Retinal fundus photograph · 2212 by 1659 pixels — 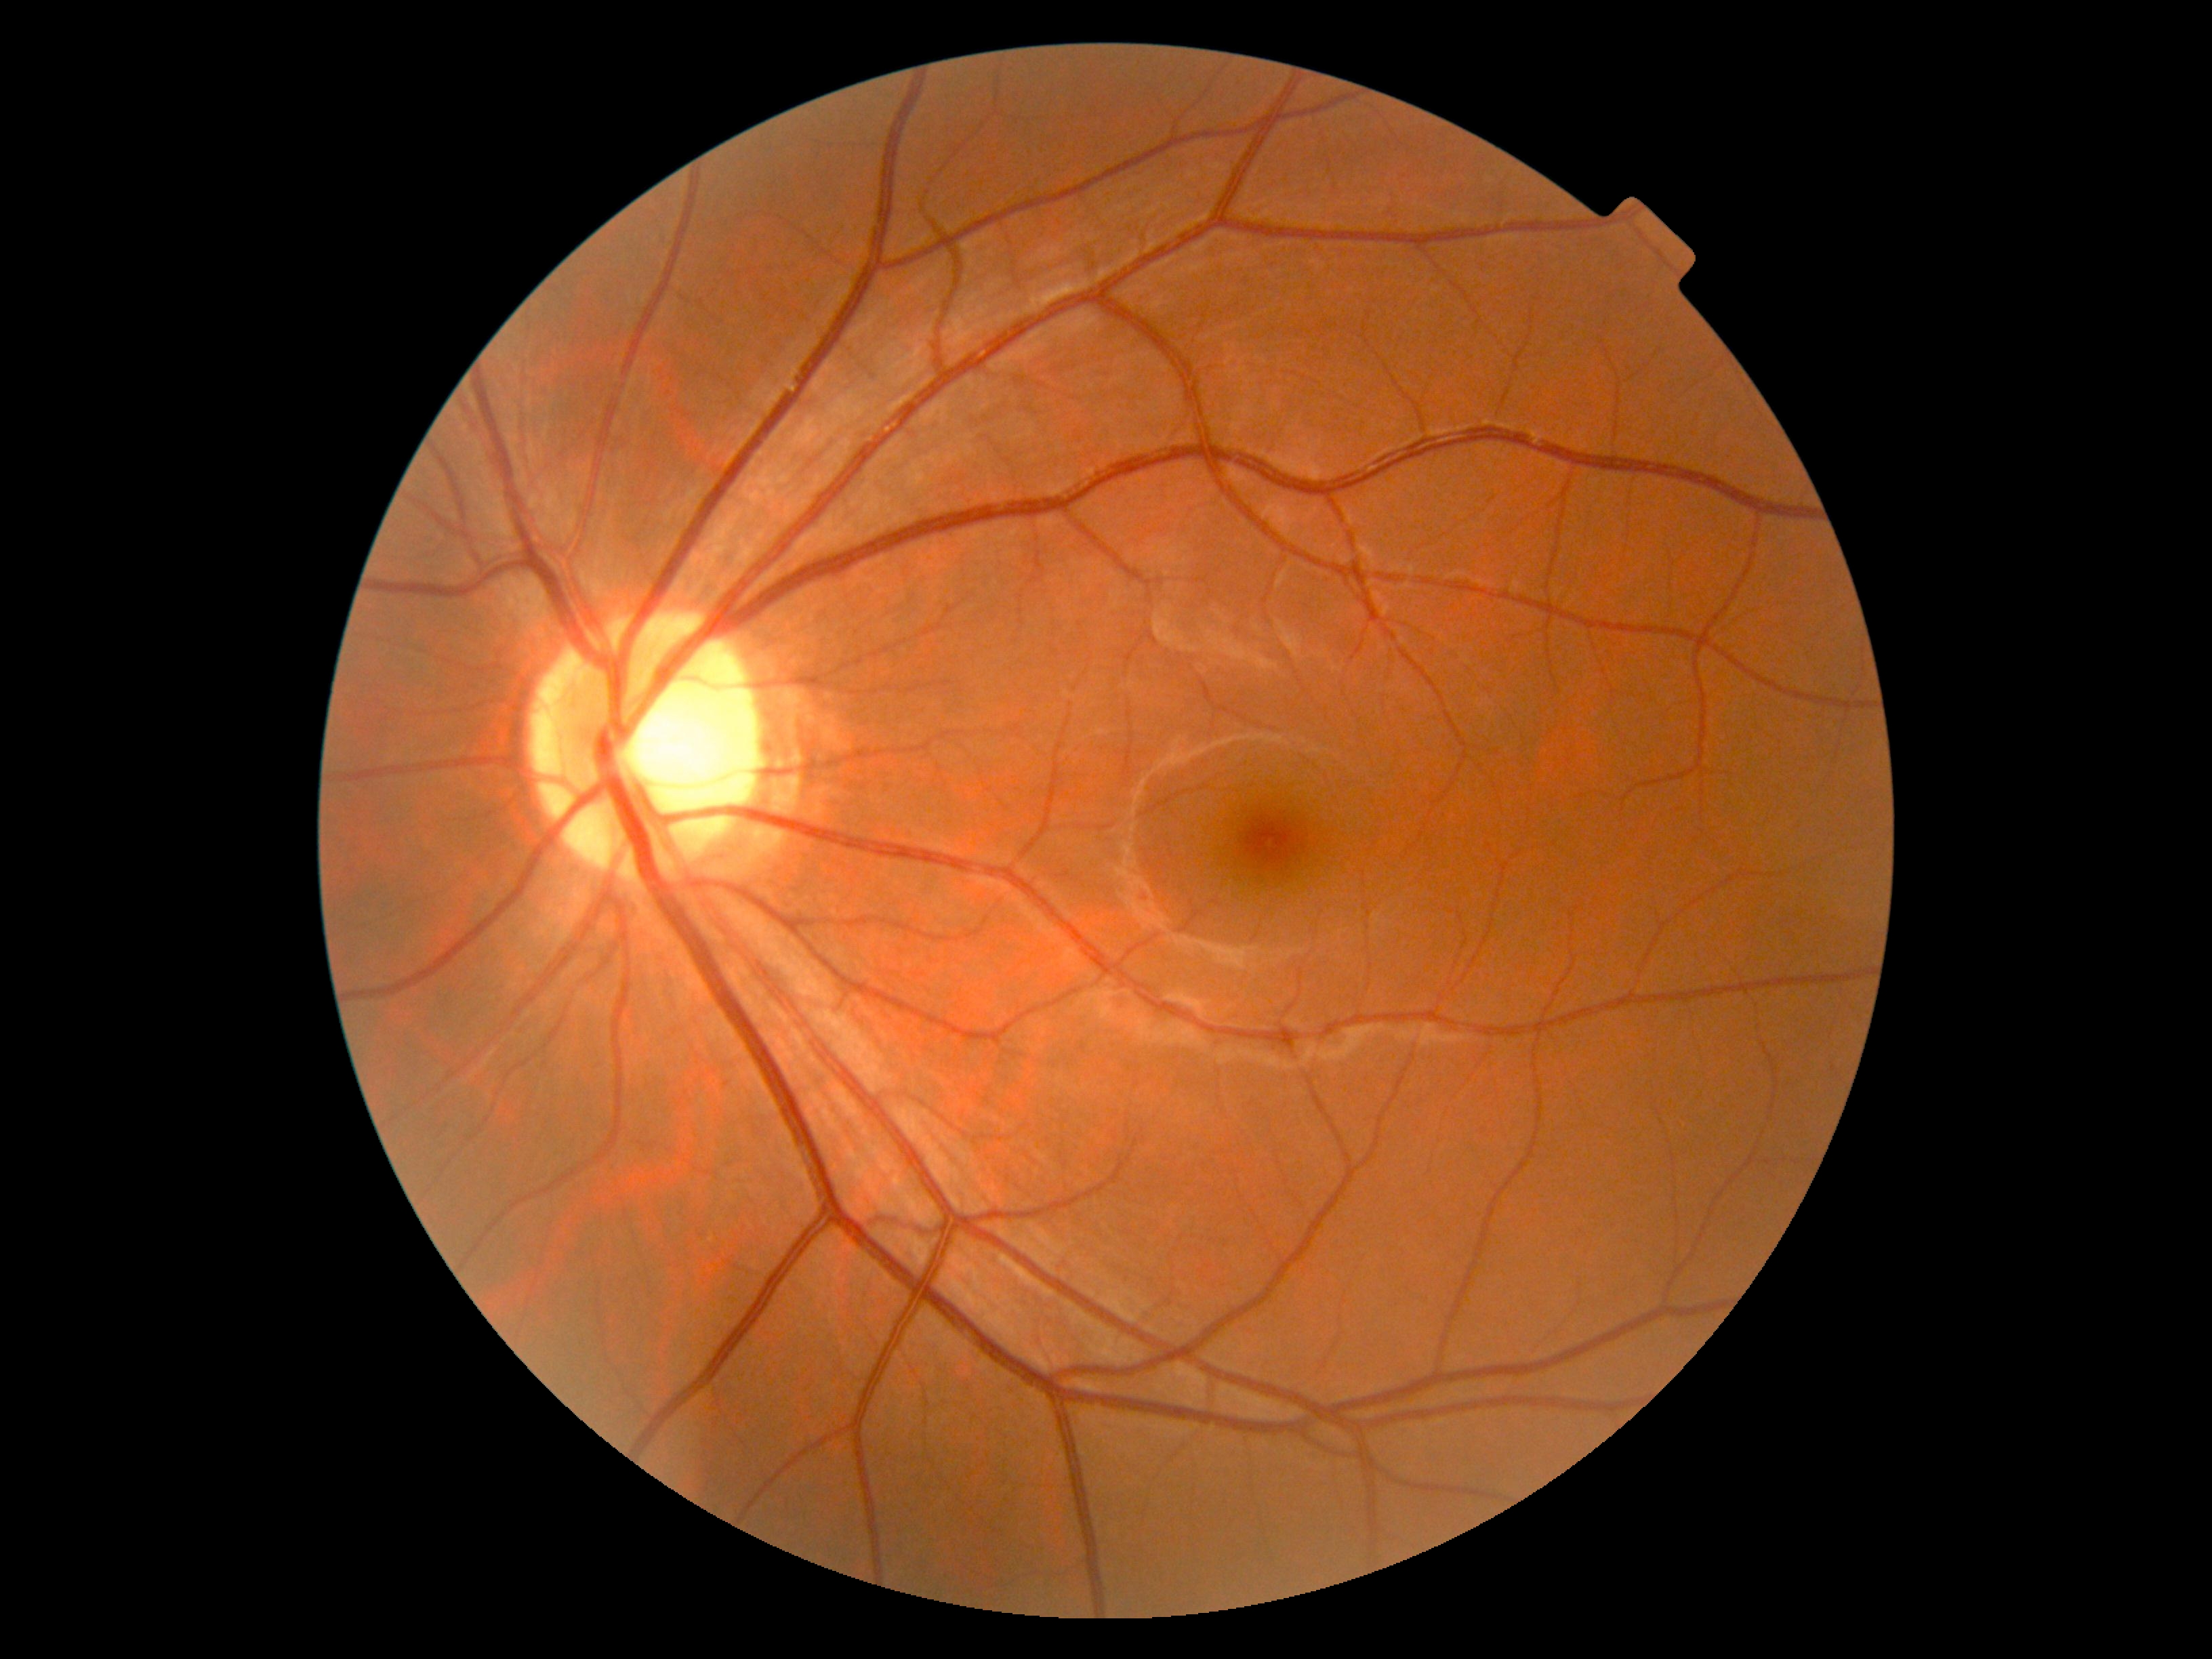
DR severity is 0/4.